Fundus photo.
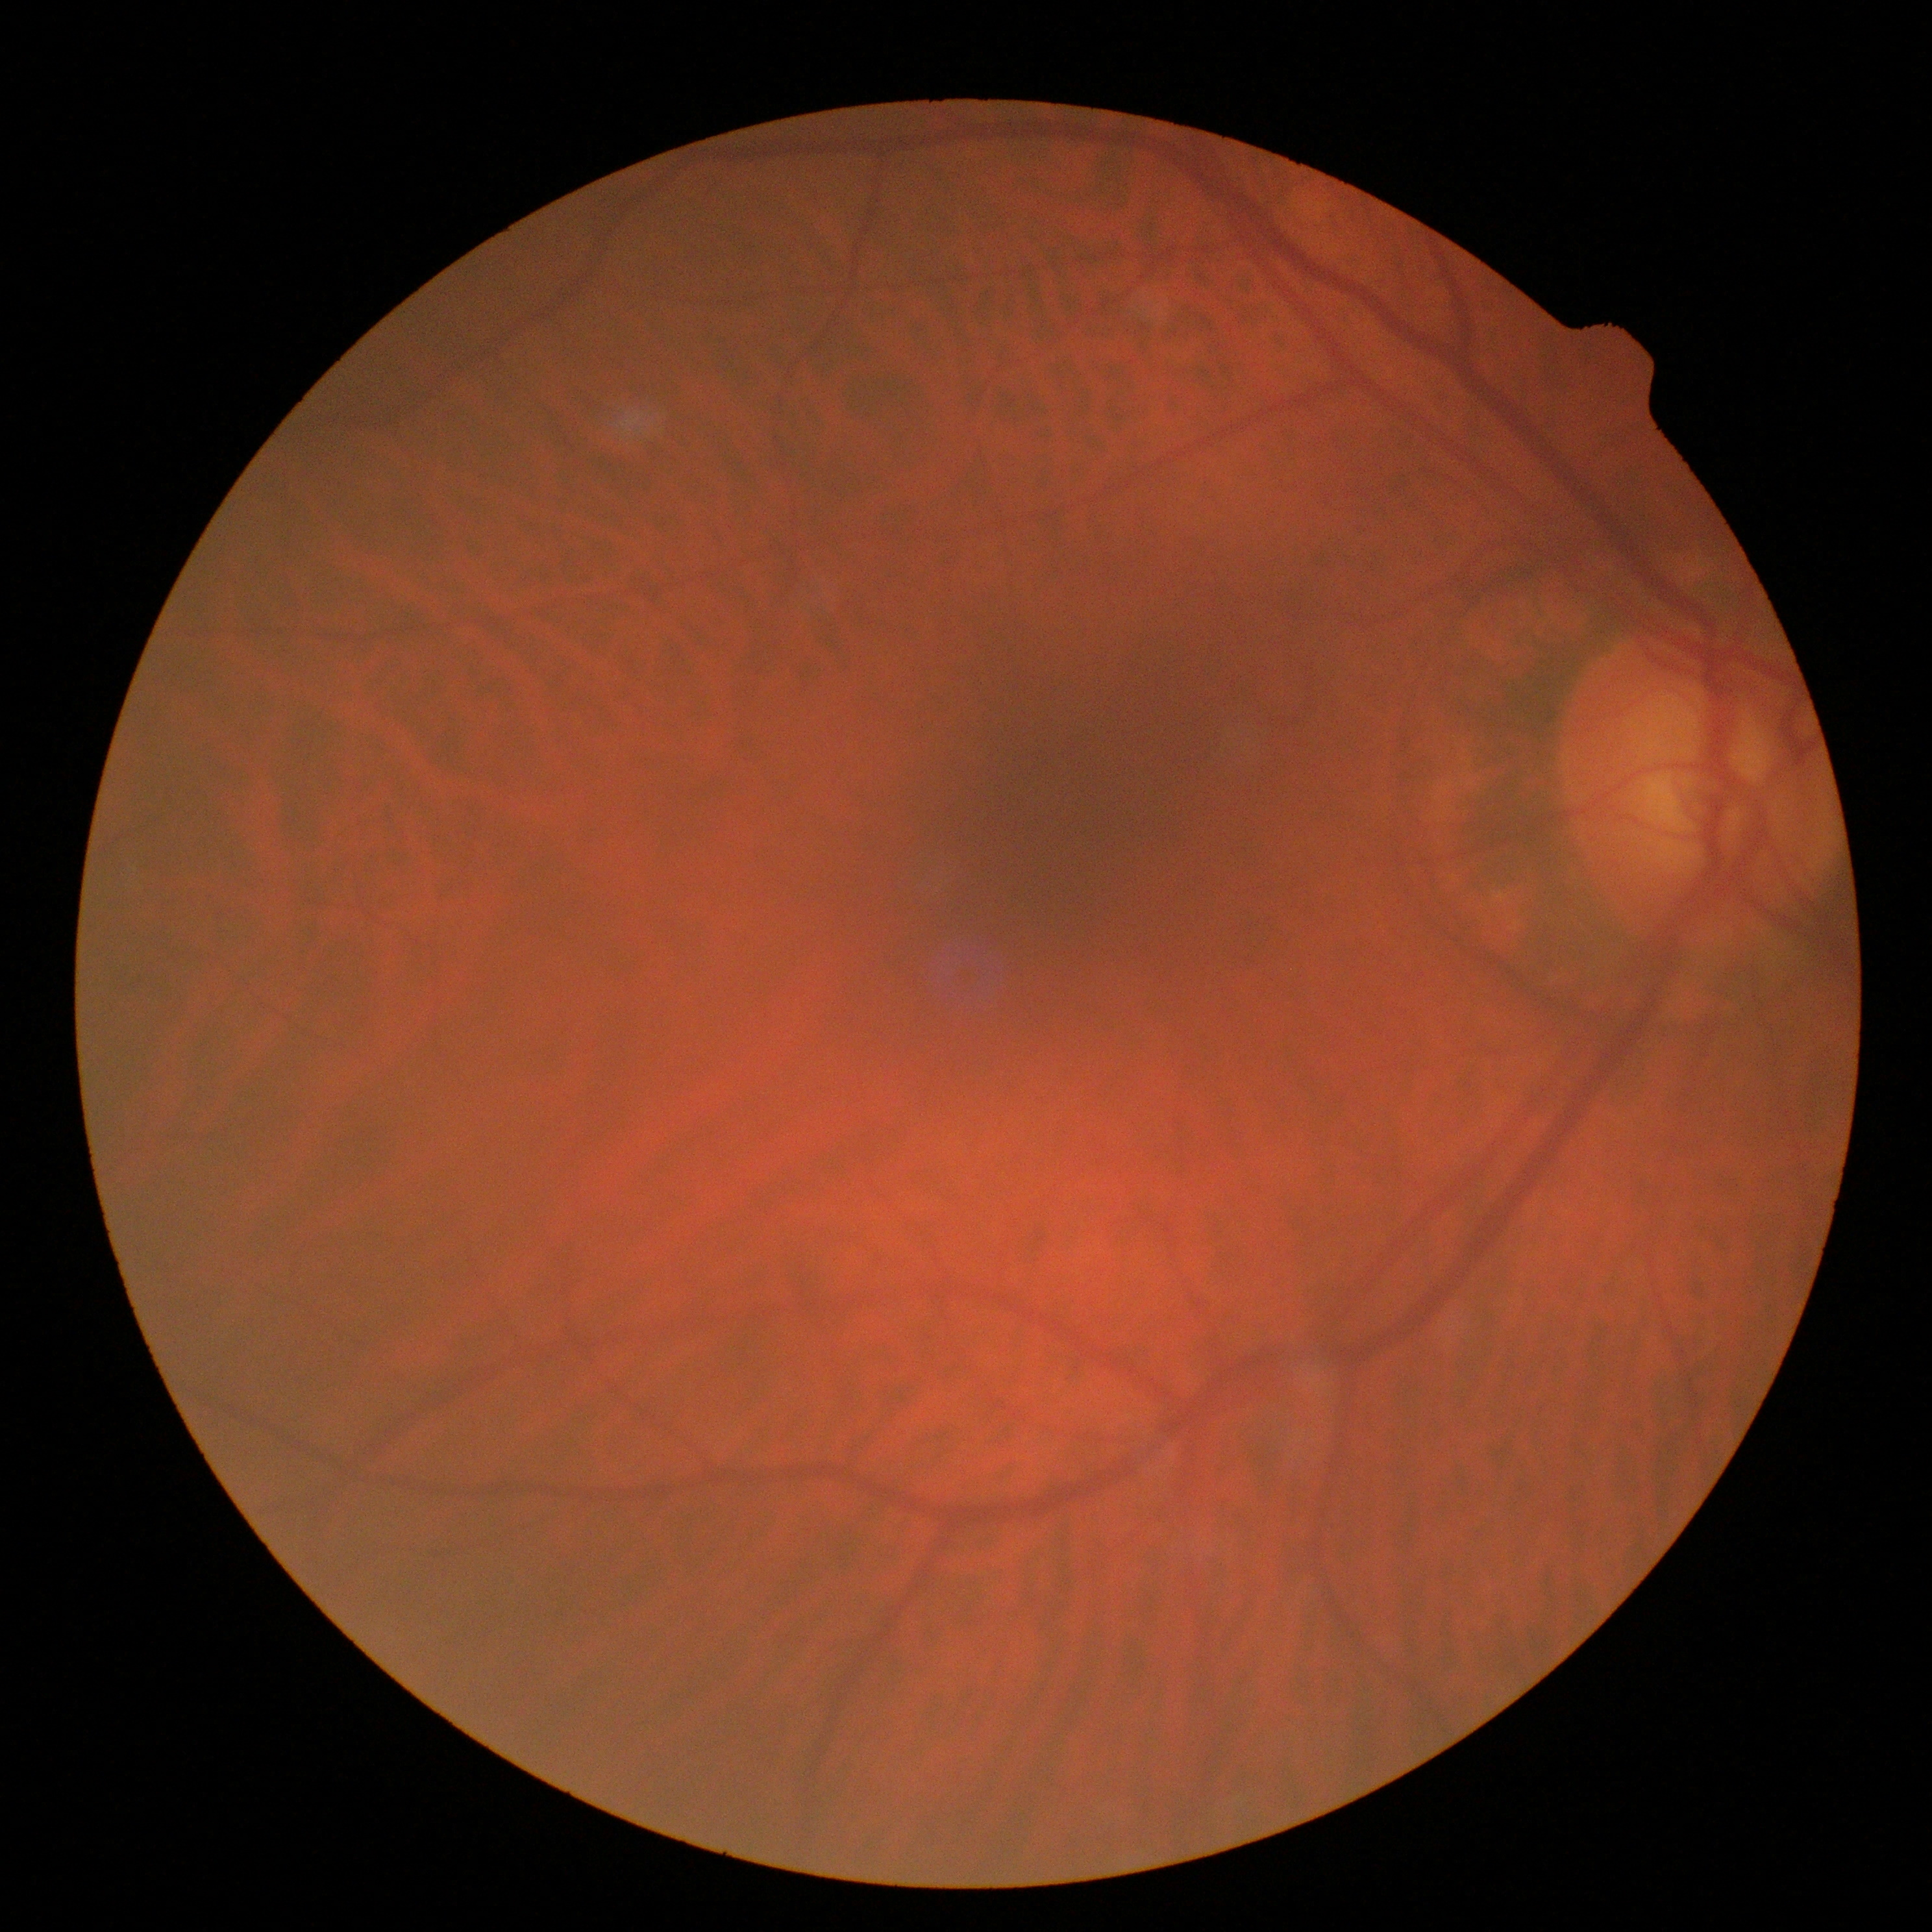
No signs of diabetic retinopathy.
DR is 0.